Wide-field fundus image from infant ROP screening.
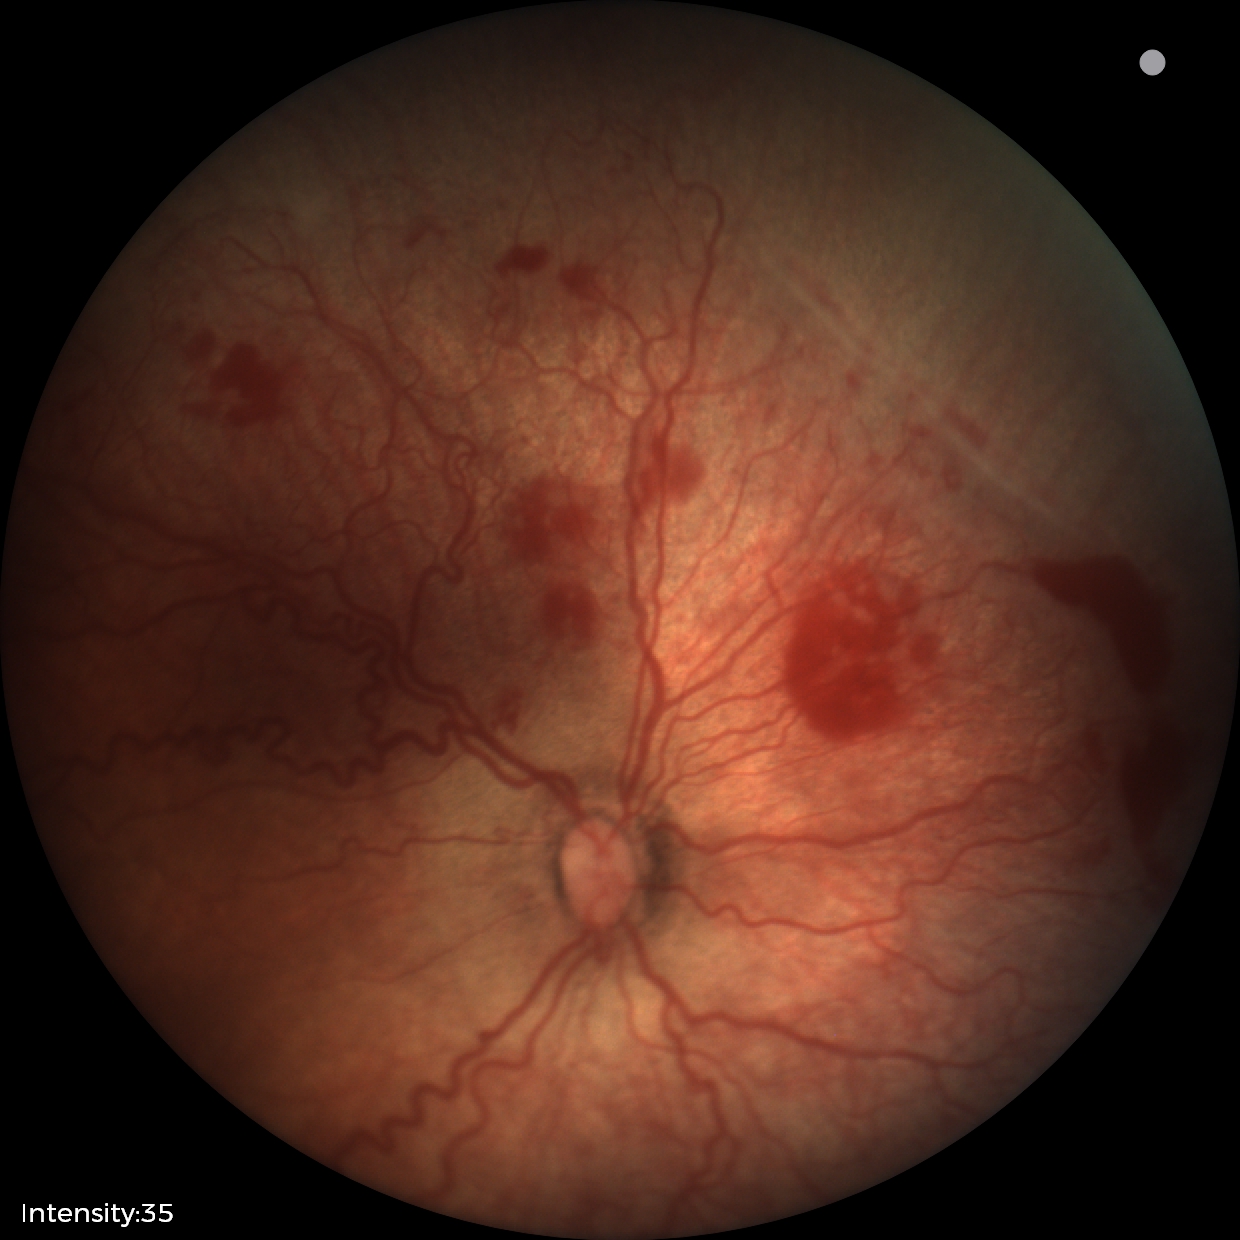
From an examination with diagnosis of ROP stage 2.